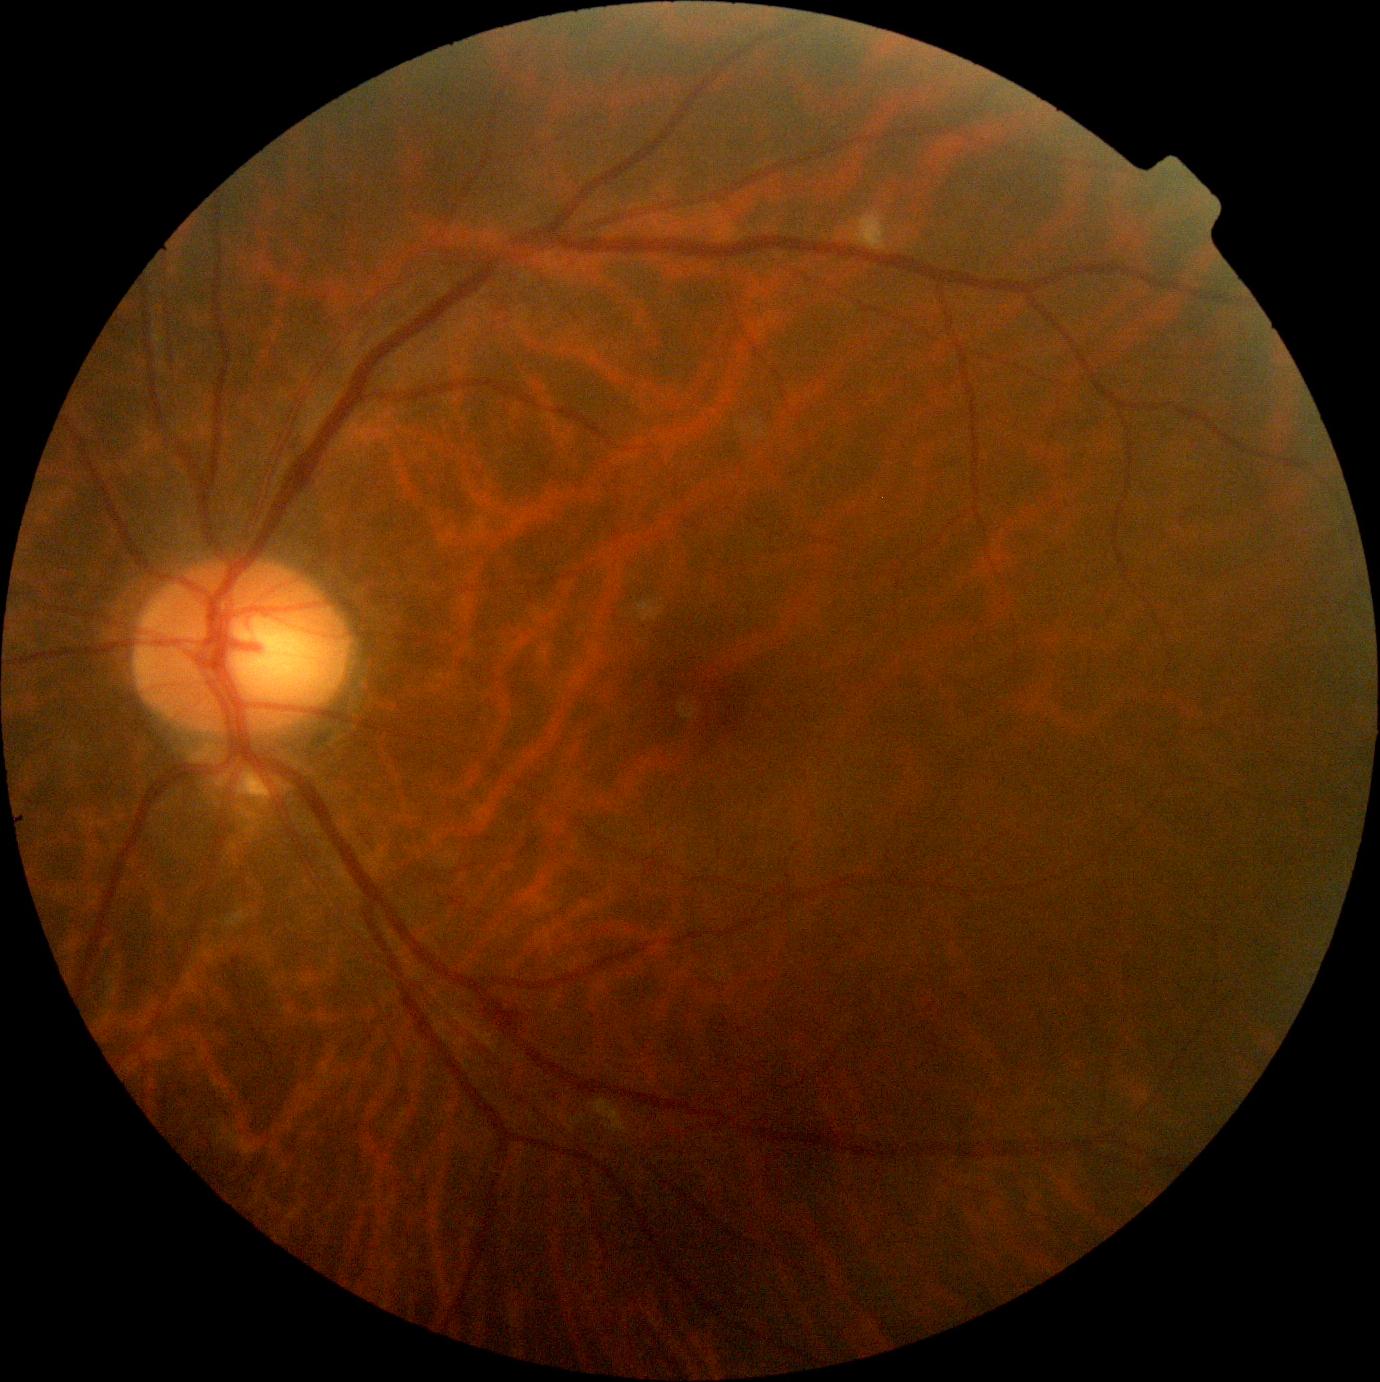
  dr_category: non-proliferative diabetic retinopathy
  dr_grade: moderate NPDR (grade 2)